Modified Davis classification — 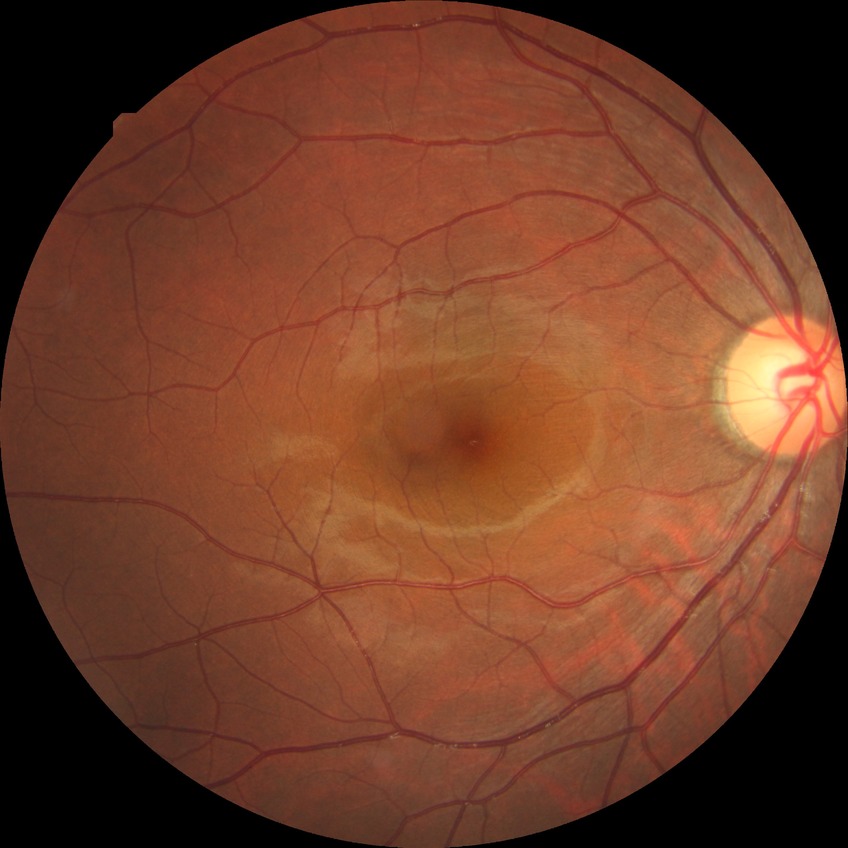
retinopathy grade: no diabetic retinopathy.